Retinal fundus photograph:
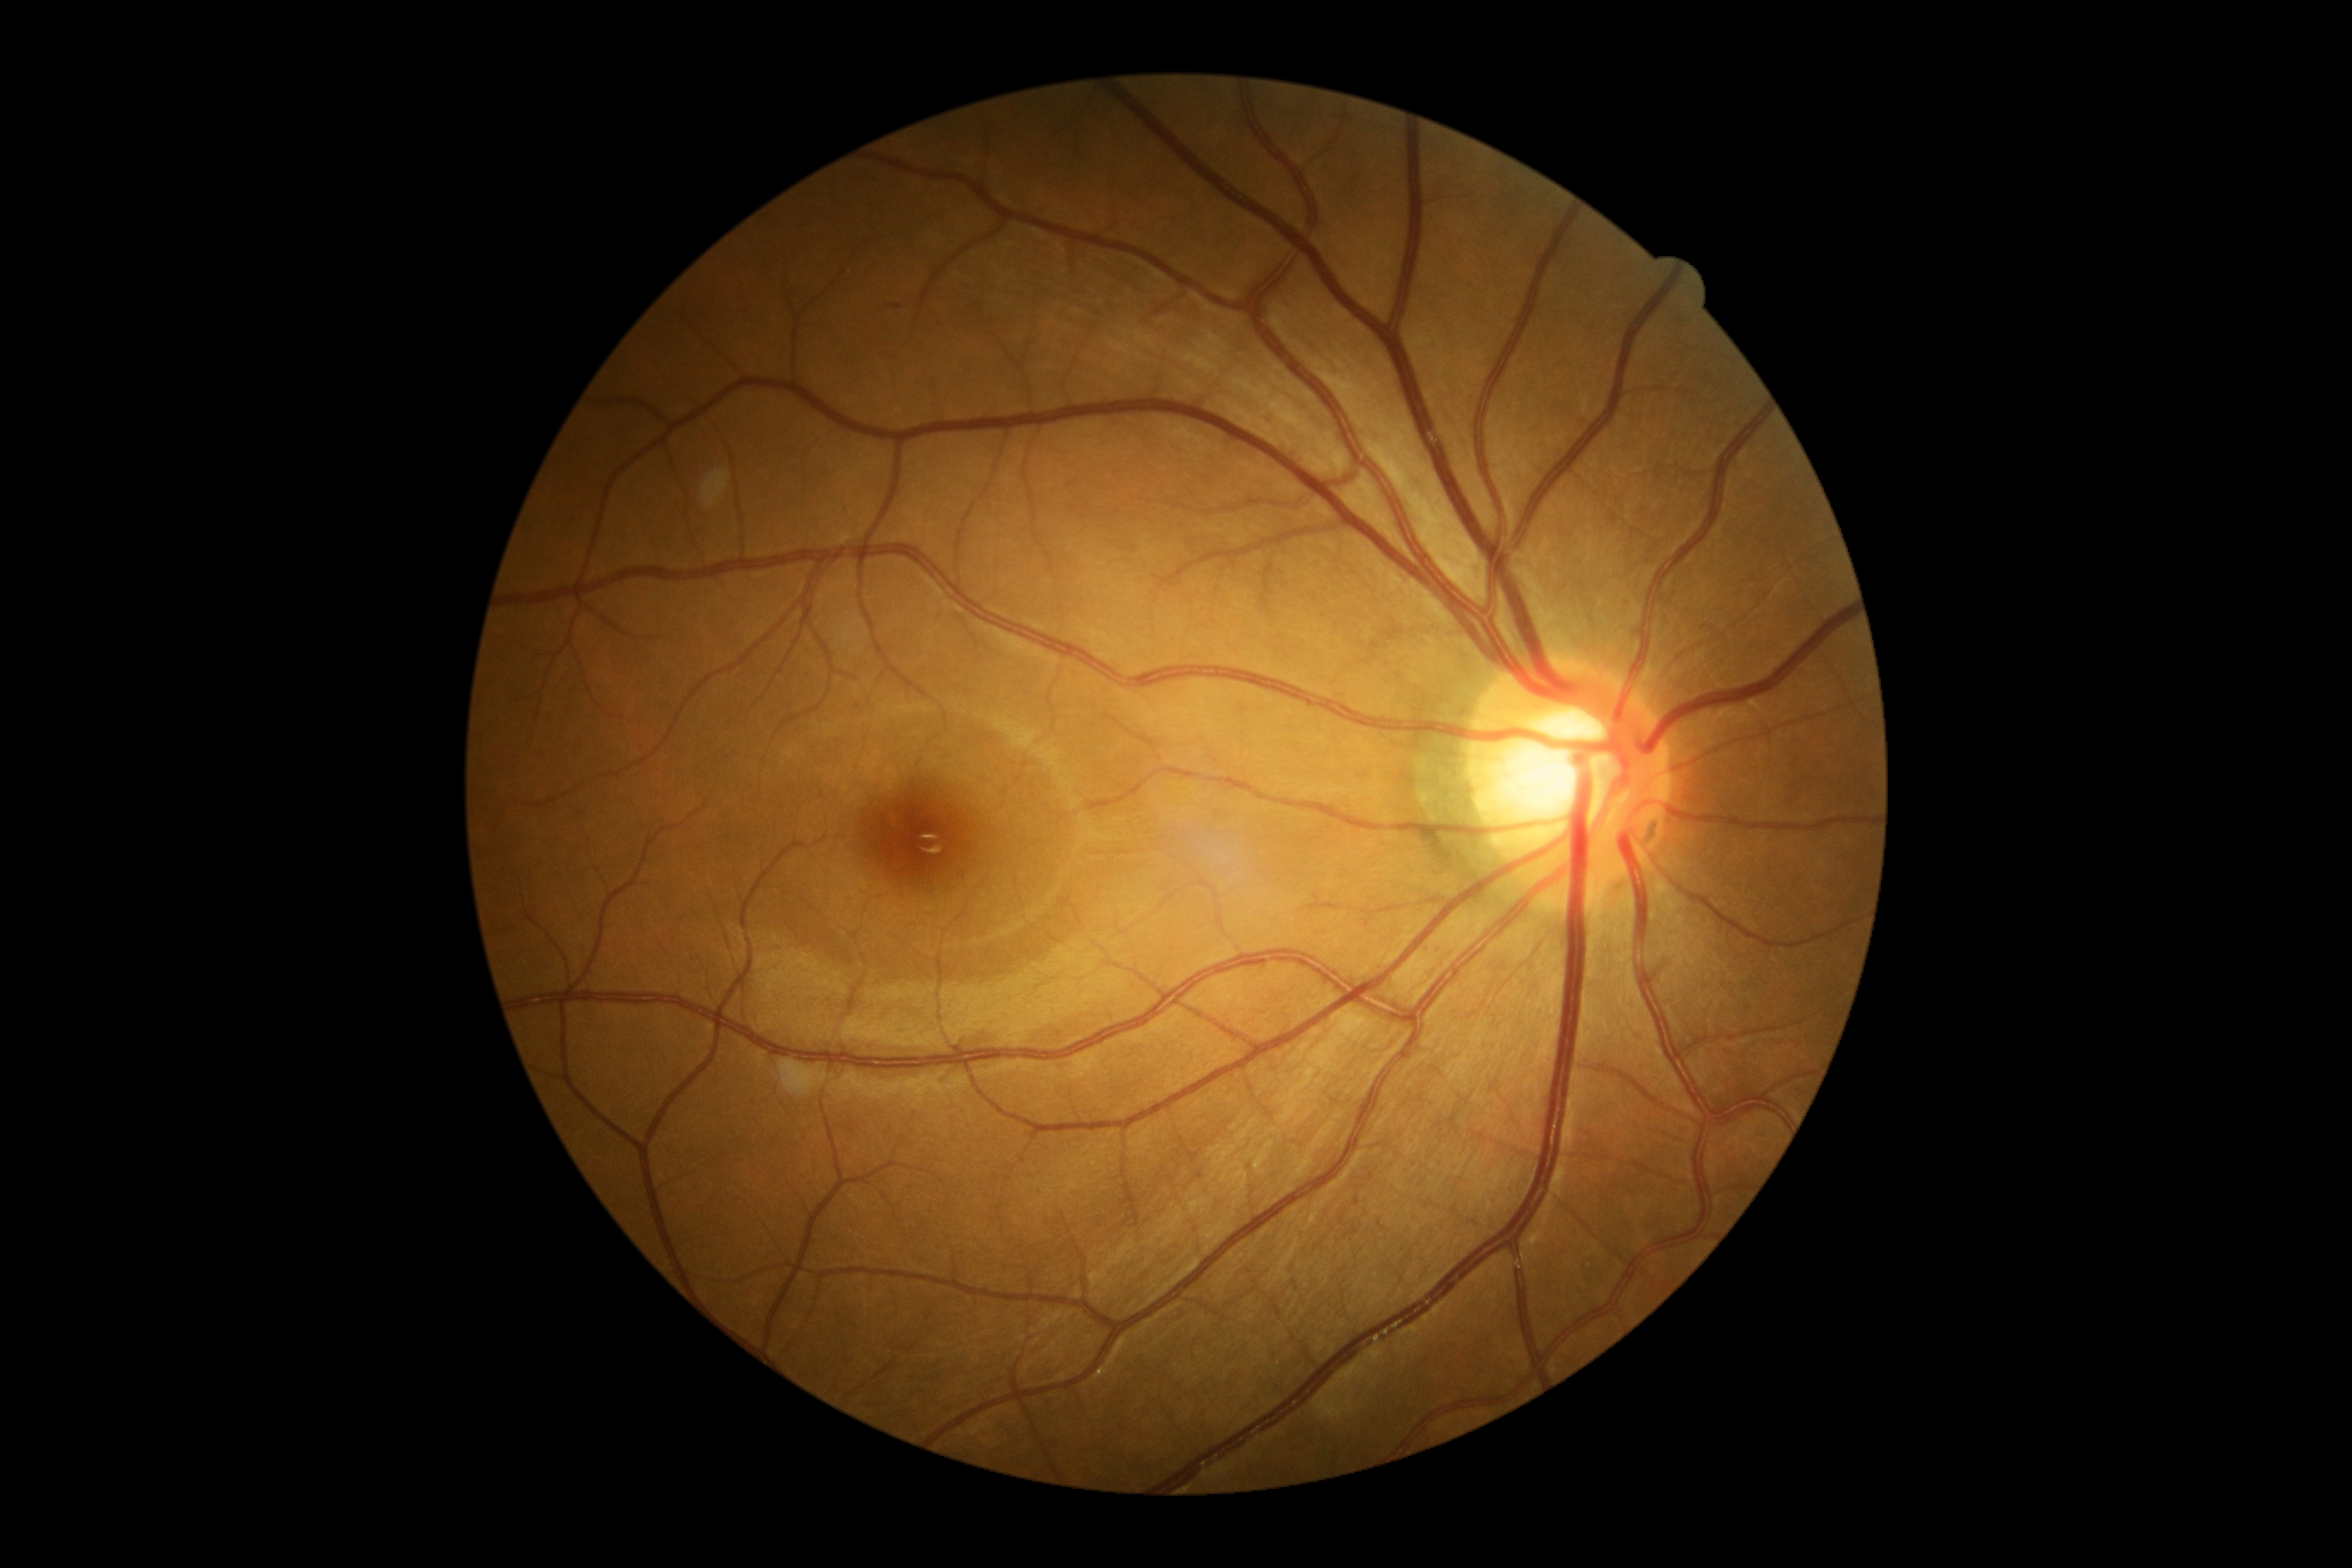

Retinopathy grade is 1. The retinopathy is classified as non-proliferative diabetic retinopathy.